2228x1652, captured after pupil dilation.
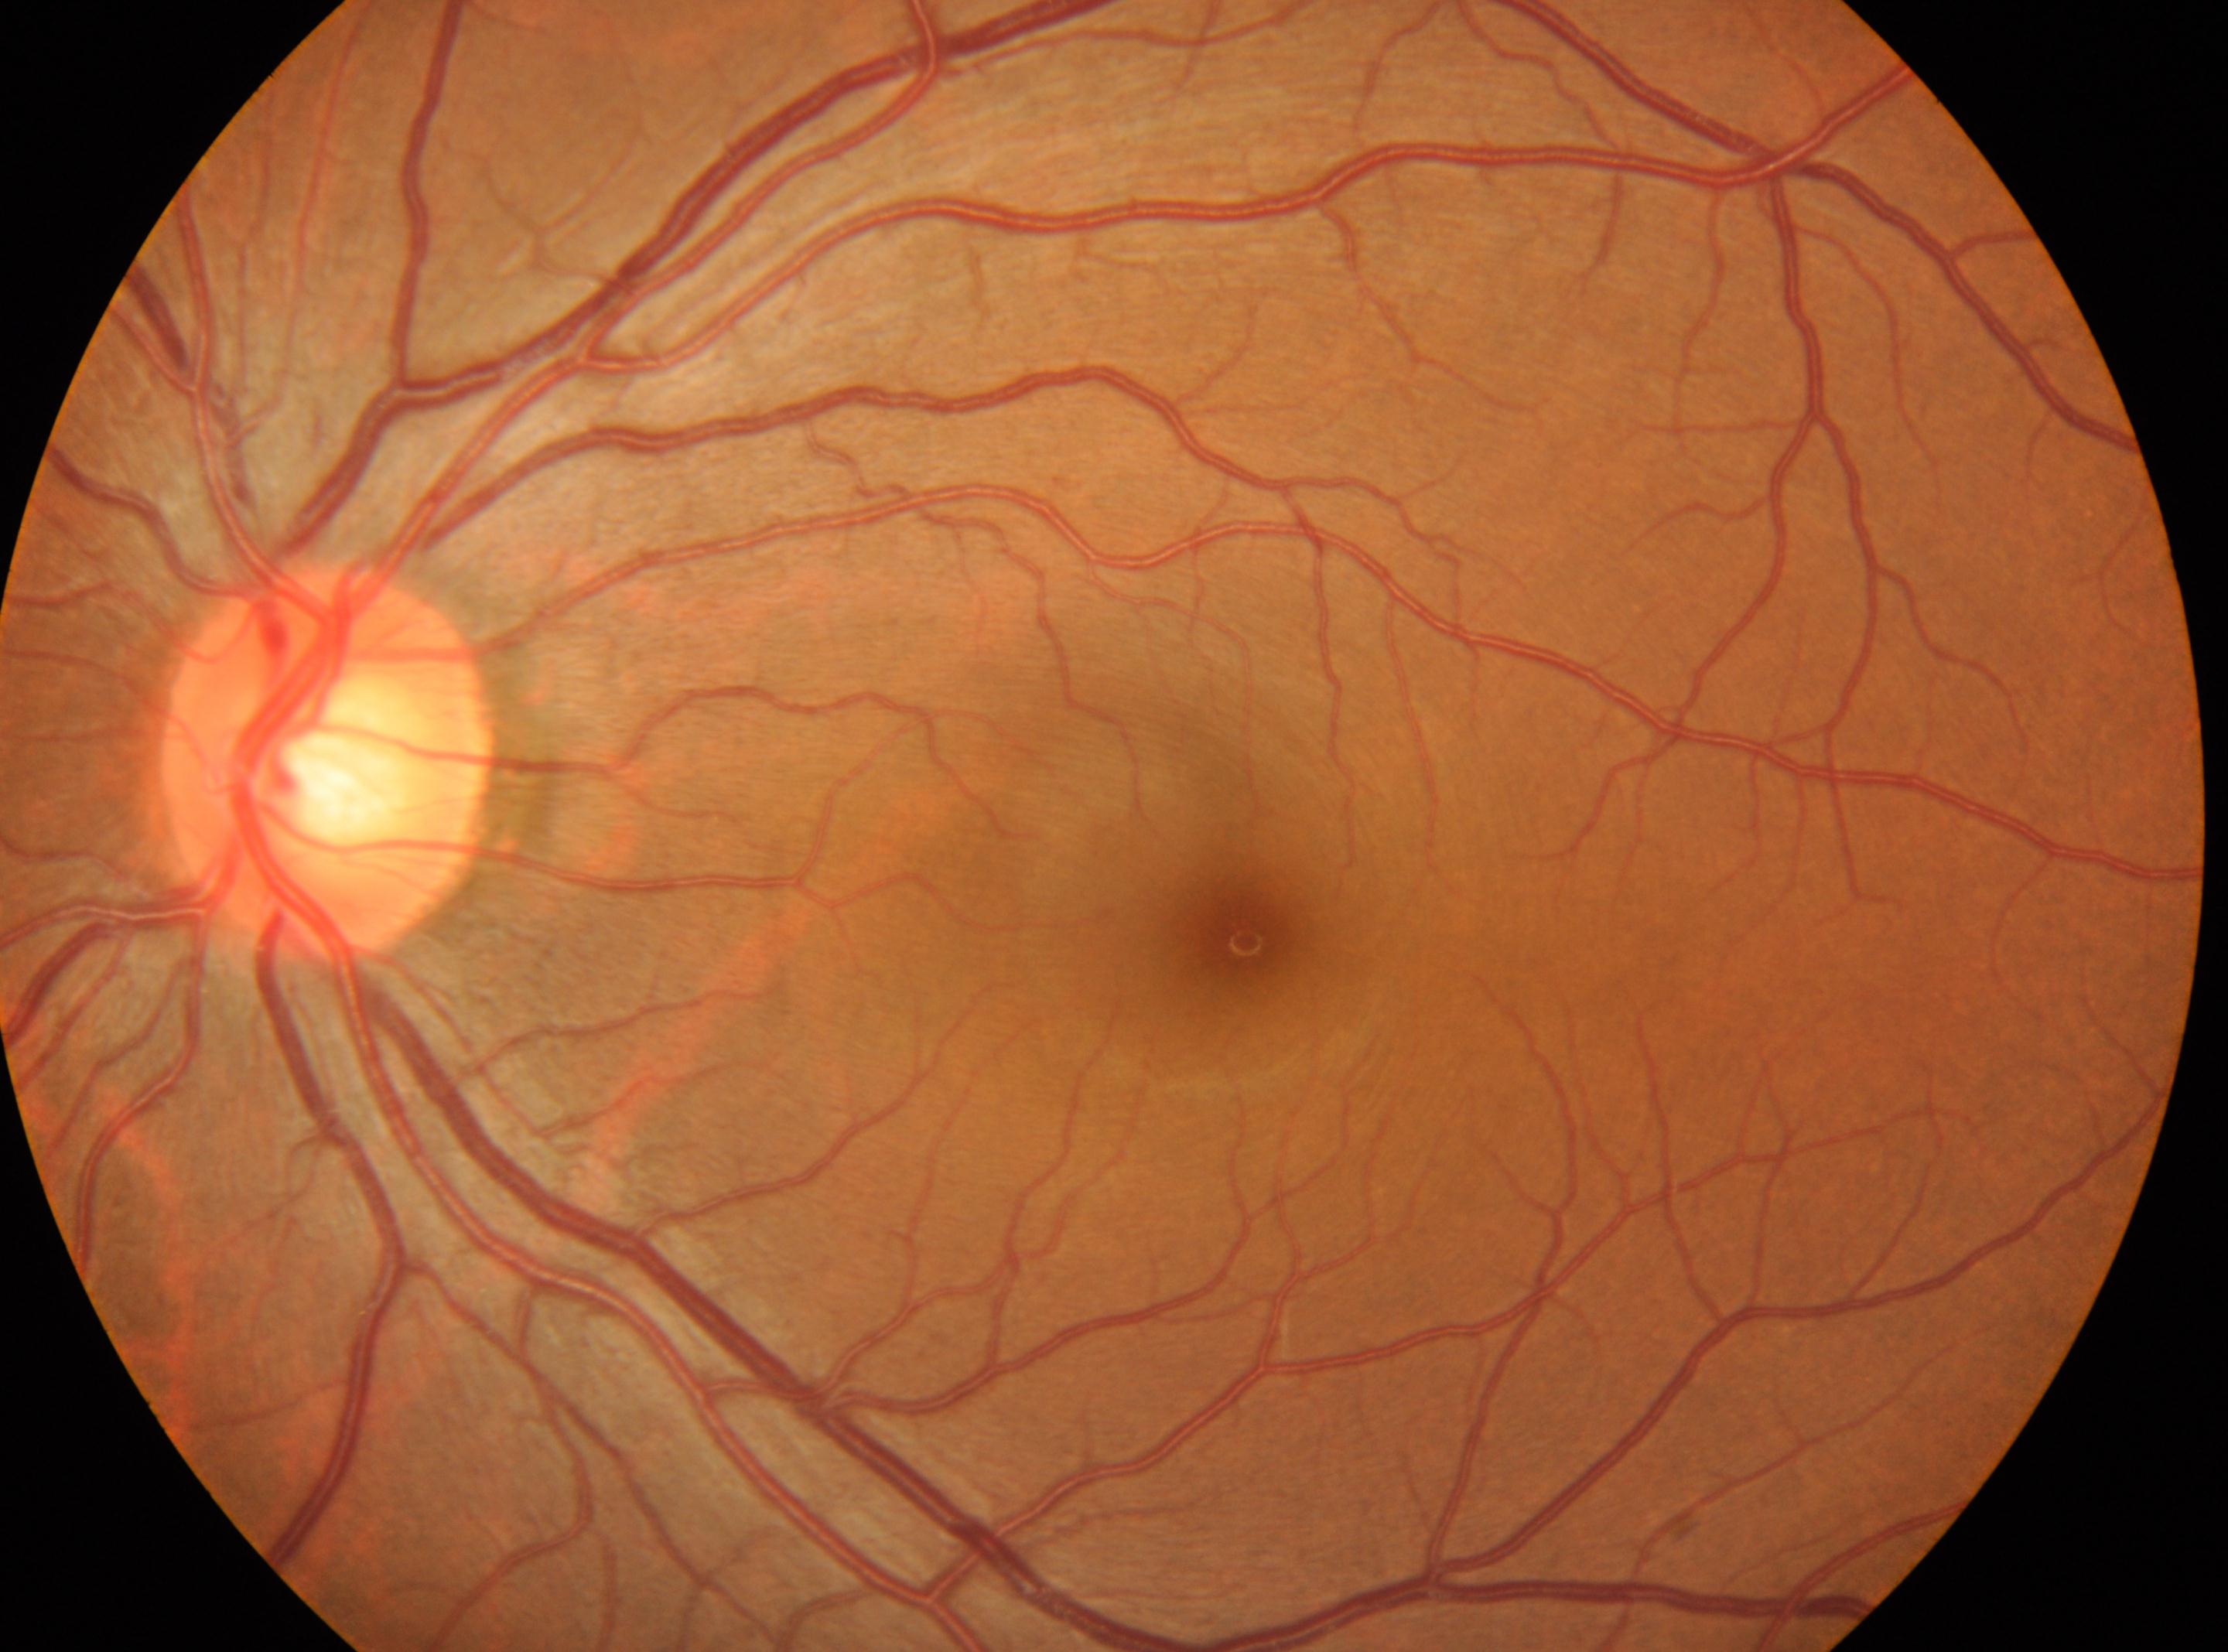 laterality: left eye | DR impression: No signs of diabetic retinopathy | DR: grade 0 | optic disc: x=326, y=766 | fovea centralis: x=1247, y=940.